2048 by 1536 pixels · CFP · 45° FOV: 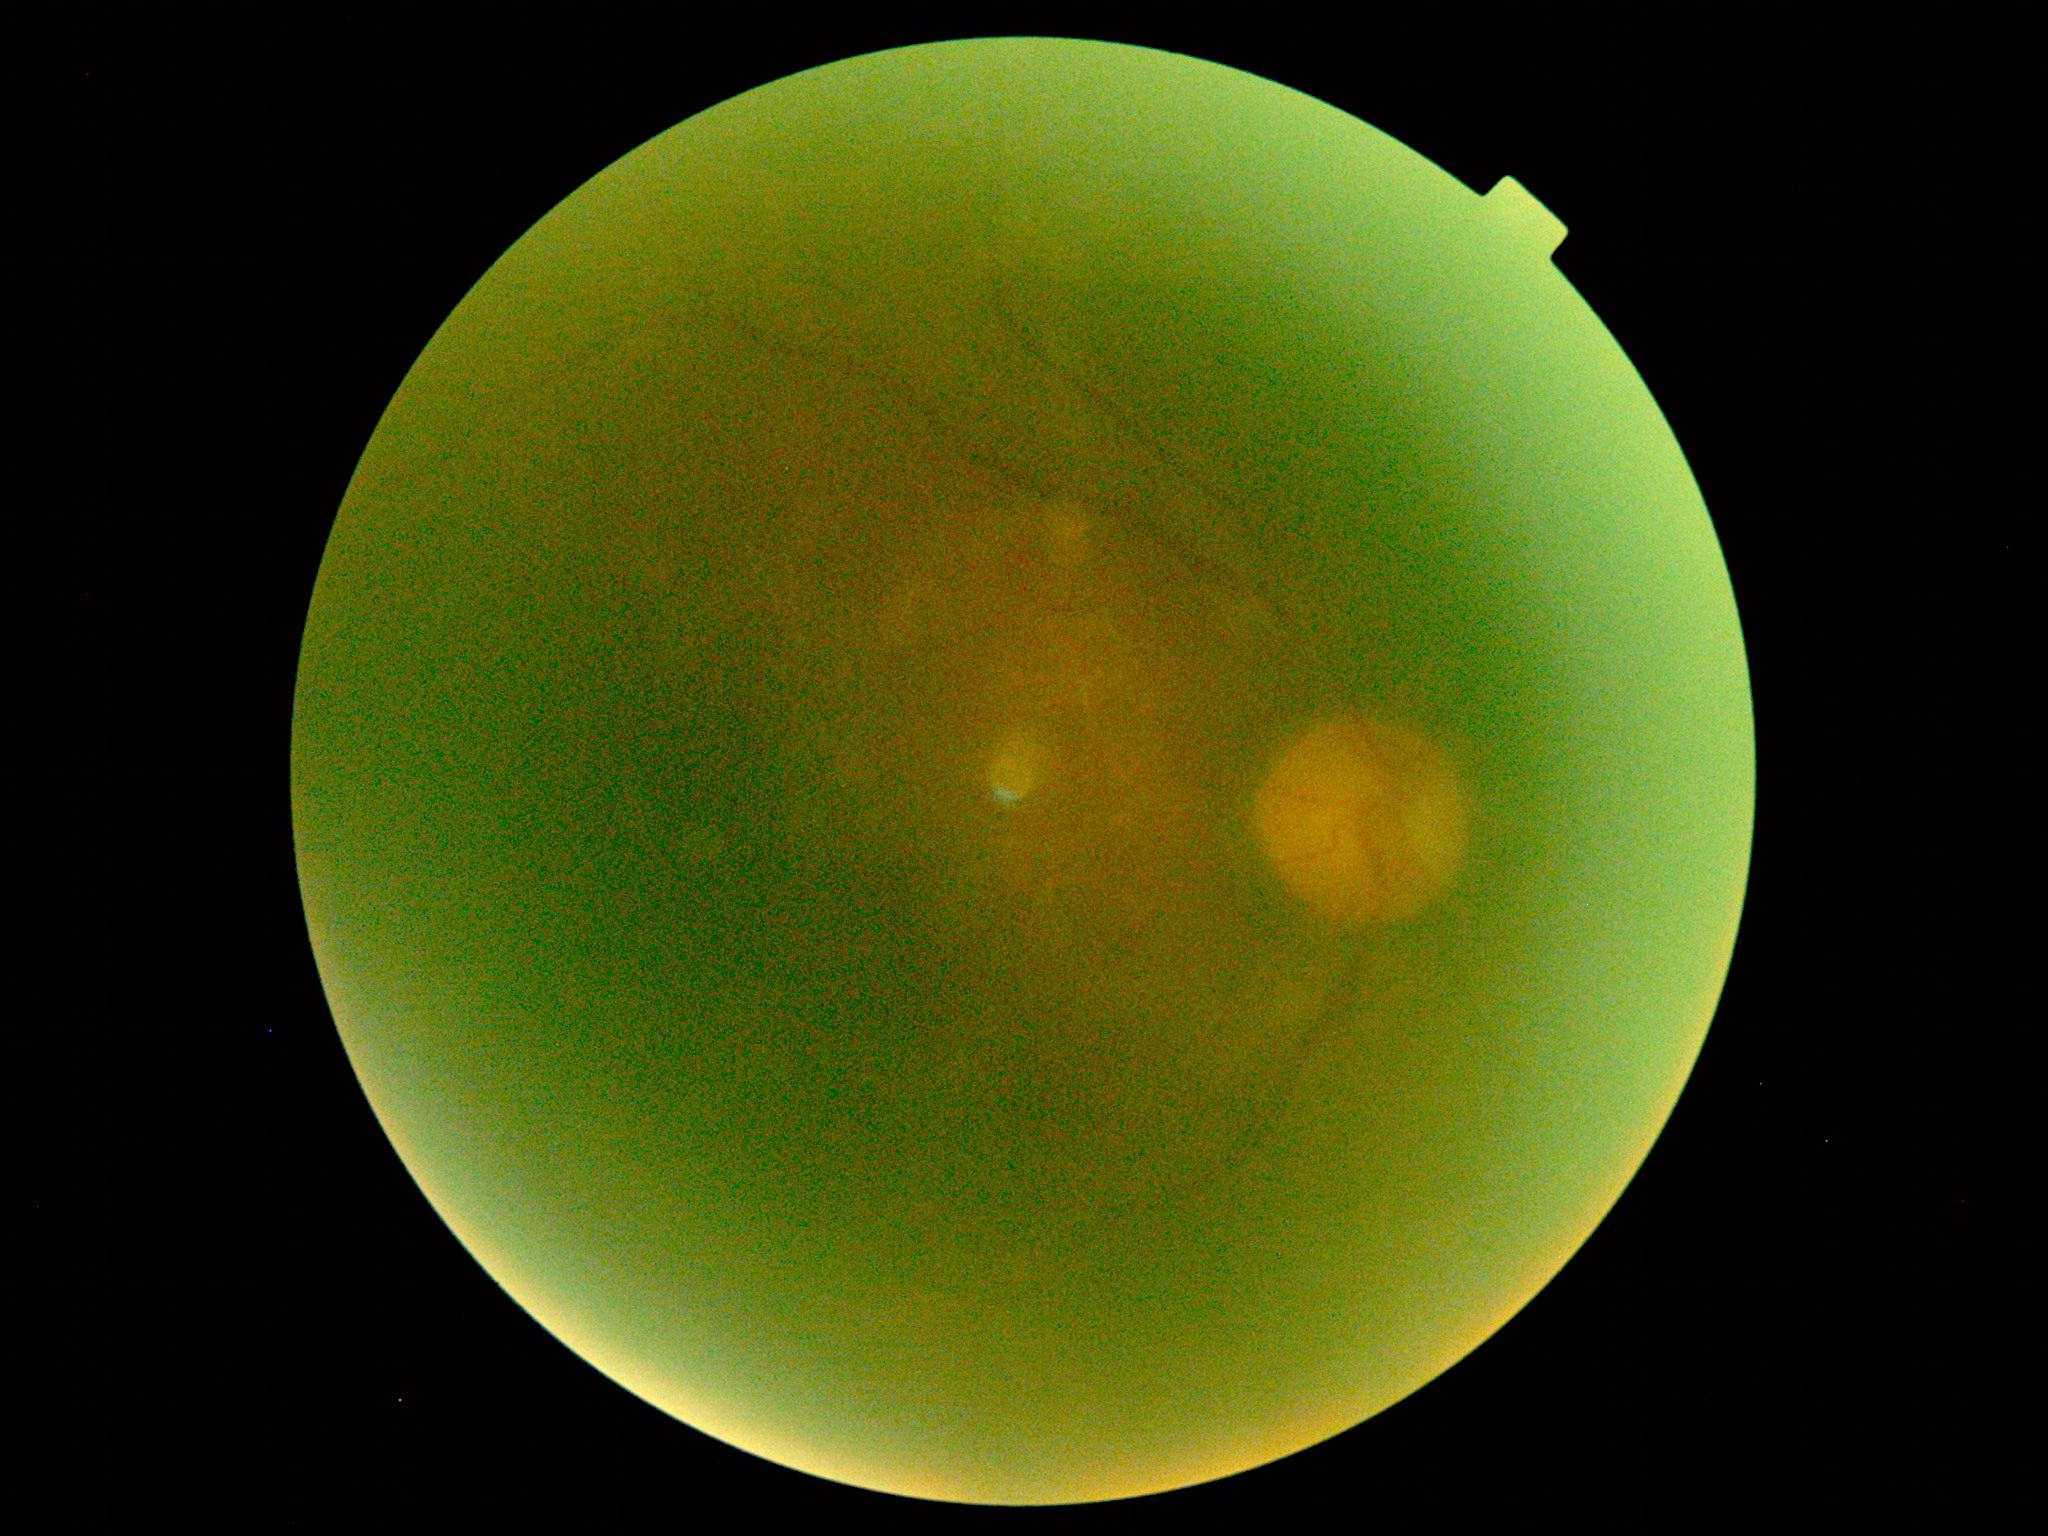
Diabetic retinopathy (DR) is ungradable.